45-degree field of view: 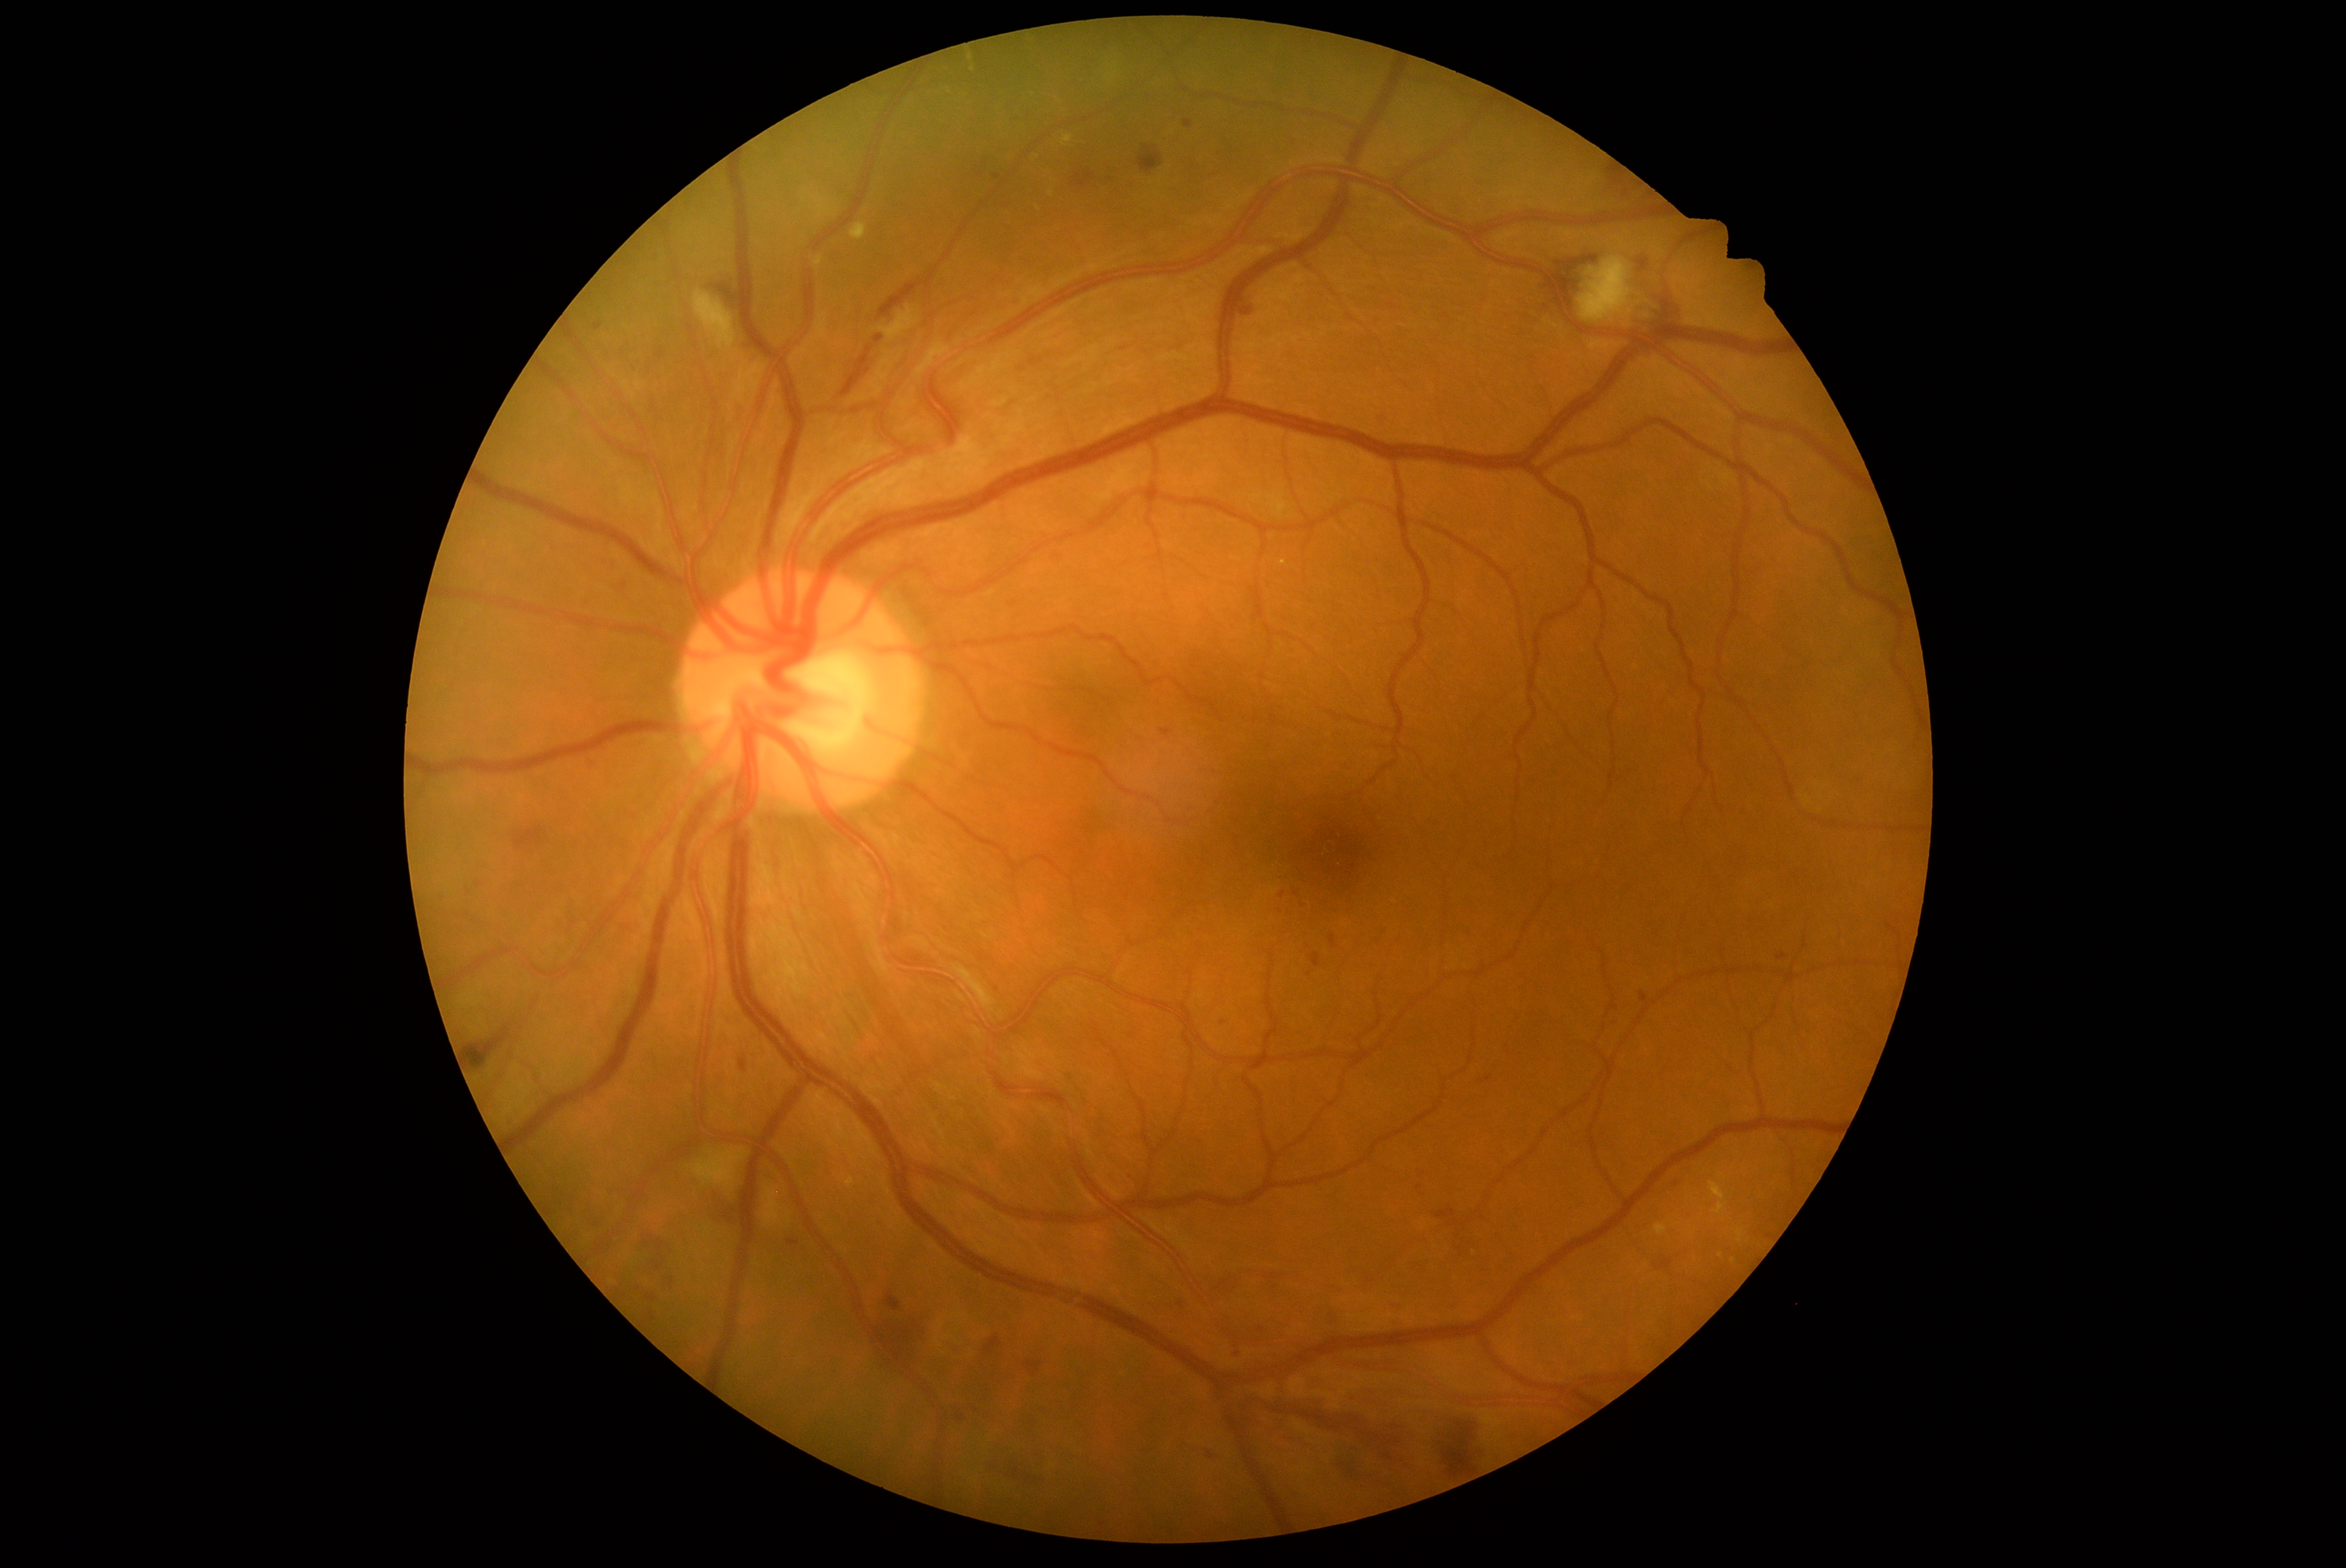 Diabetic retinopathy (DR): grade 2 (moderate NPDR)
Representative lesions:
hemorrhages (HEs) (partial): <bbox>877, 1312, 929, 1362</bbox>, <bbox>1390, 1301, 1403, 1305</bbox>, <bbox>1138, 147, 1163, 173</bbox>, <bbox>1026, 1363, 1040, 1371</bbox>, <bbox>1161, 730, 1171, 738</bbox>, <bbox>1660, 300, 1672, 327</bbox>, <bbox>1000, 1470, 1045, 1487</bbox>, <bbox>1312, 953, 1321, 968</bbox>, <bbox>1073, 172, 1094, 191</bbox>, <bbox>1247, 1392, 1420, 1465</bbox>, <bbox>1657, 1261, 1674, 1271</bbox>, <bbox>1436, 1210, 1456, 1219</bbox>, <bbox>644, 1233, 674, 1269</bbox>, <bbox>879, 285, 918, 319</bbox>, <bbox>467, 1029, 509, 1072</bbox>
HEs (small, approximate centers) near (1125, 349)
soft exudates (SEs): <bbox>879, 307, 918, 343</bbox>, <bbox>694, 292, 736, 352</bbox>, <bbox>1578, 258, 1633, 324</bbox>, <bbox>694, 1150, 746, 1192</bbox>
microaneurysms (MAs) (partial): <bbox>876, 335, 884, 344</bbox>, <bbox>1241, 303, 1255, 318</bbox>, <bbox>1177, 1299, 1185, 1304</bbox>, <bbox>1778, 954, 1787, 960</bbox>, <bbox>739, 1059, 747, 1072</bbox>, <bbox>1641, 993, 1649, 1003</bbox>
MAs (small, approximate centers) near (1307, 905), (1296, 894), (962, 1419), (1677, 1185), (1459, 1305), (998, 178)
hard exudates (EXs) (partial): <bbox>851, 225, 868, 241</bbox>, <bbox>1709, 1181, 1726, 1214</bbox>, <bbox>1064, 136, 1072, 143</bbox>, <bbox>1655, 1224, 1668, 1236</bbox>
EXs (small, approximate centers) near (969, 57), (1283, 563), (1733, 1262), (1051, 193)